Acquired on the Phoenix ICON · wide-field fundus photograph from neonatal ROP screening
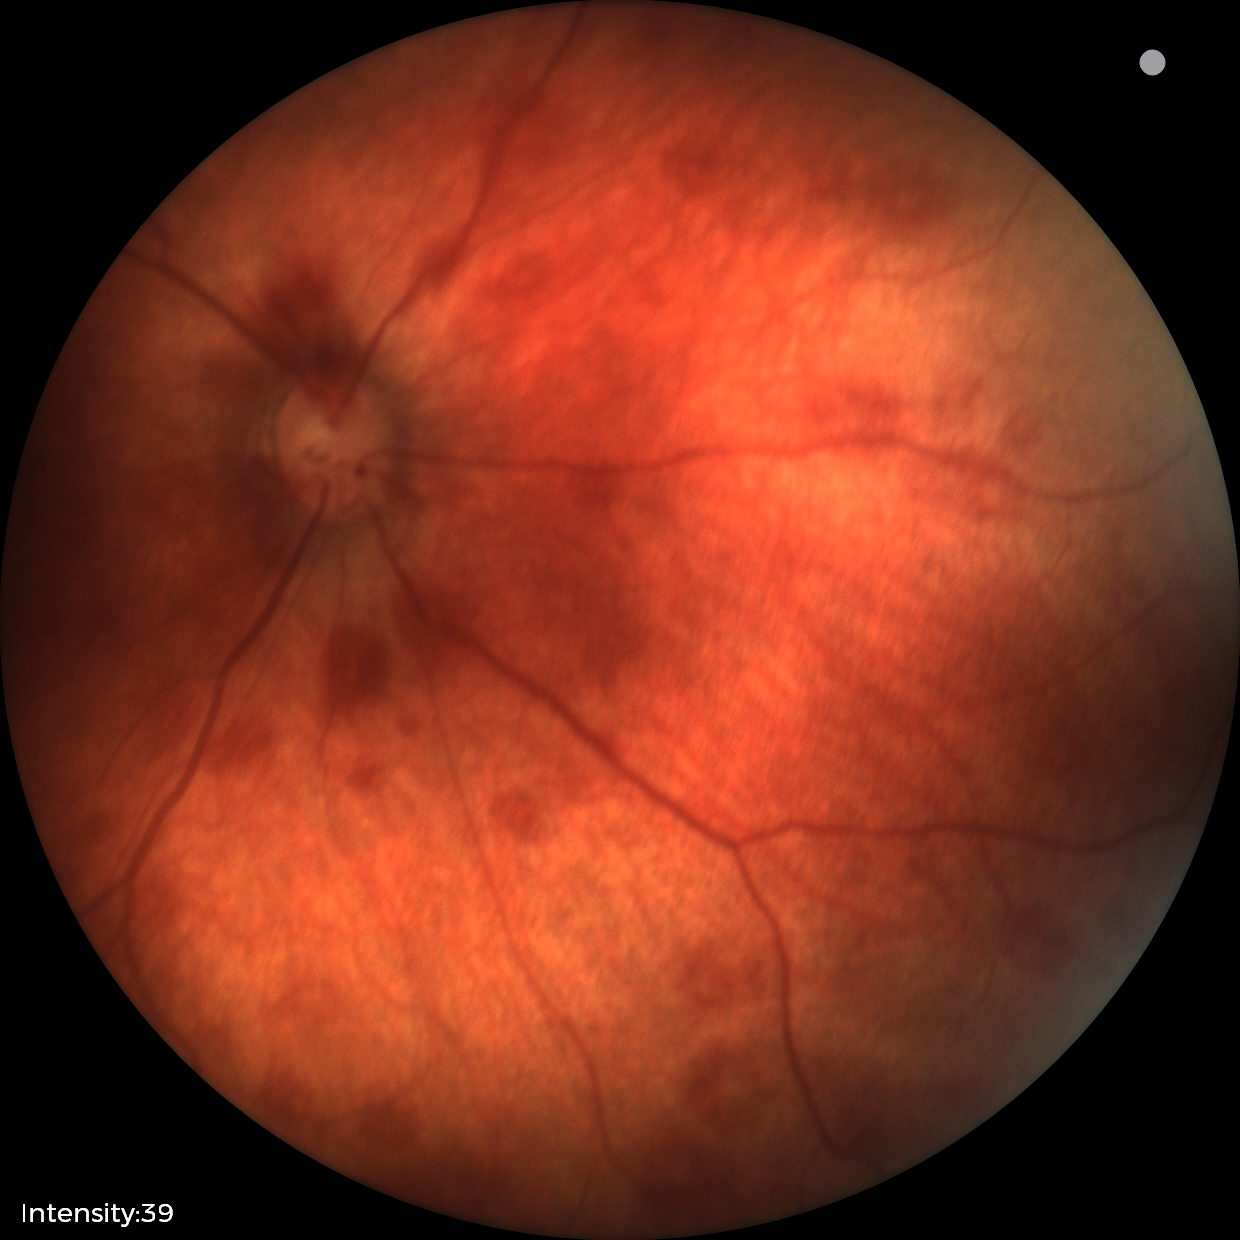
Screening examination consistent with retinal hemorrhages.